Refractive error: +0.25 -0.75 x 75; optic disc at the center of the field; 30° field of view; man patient
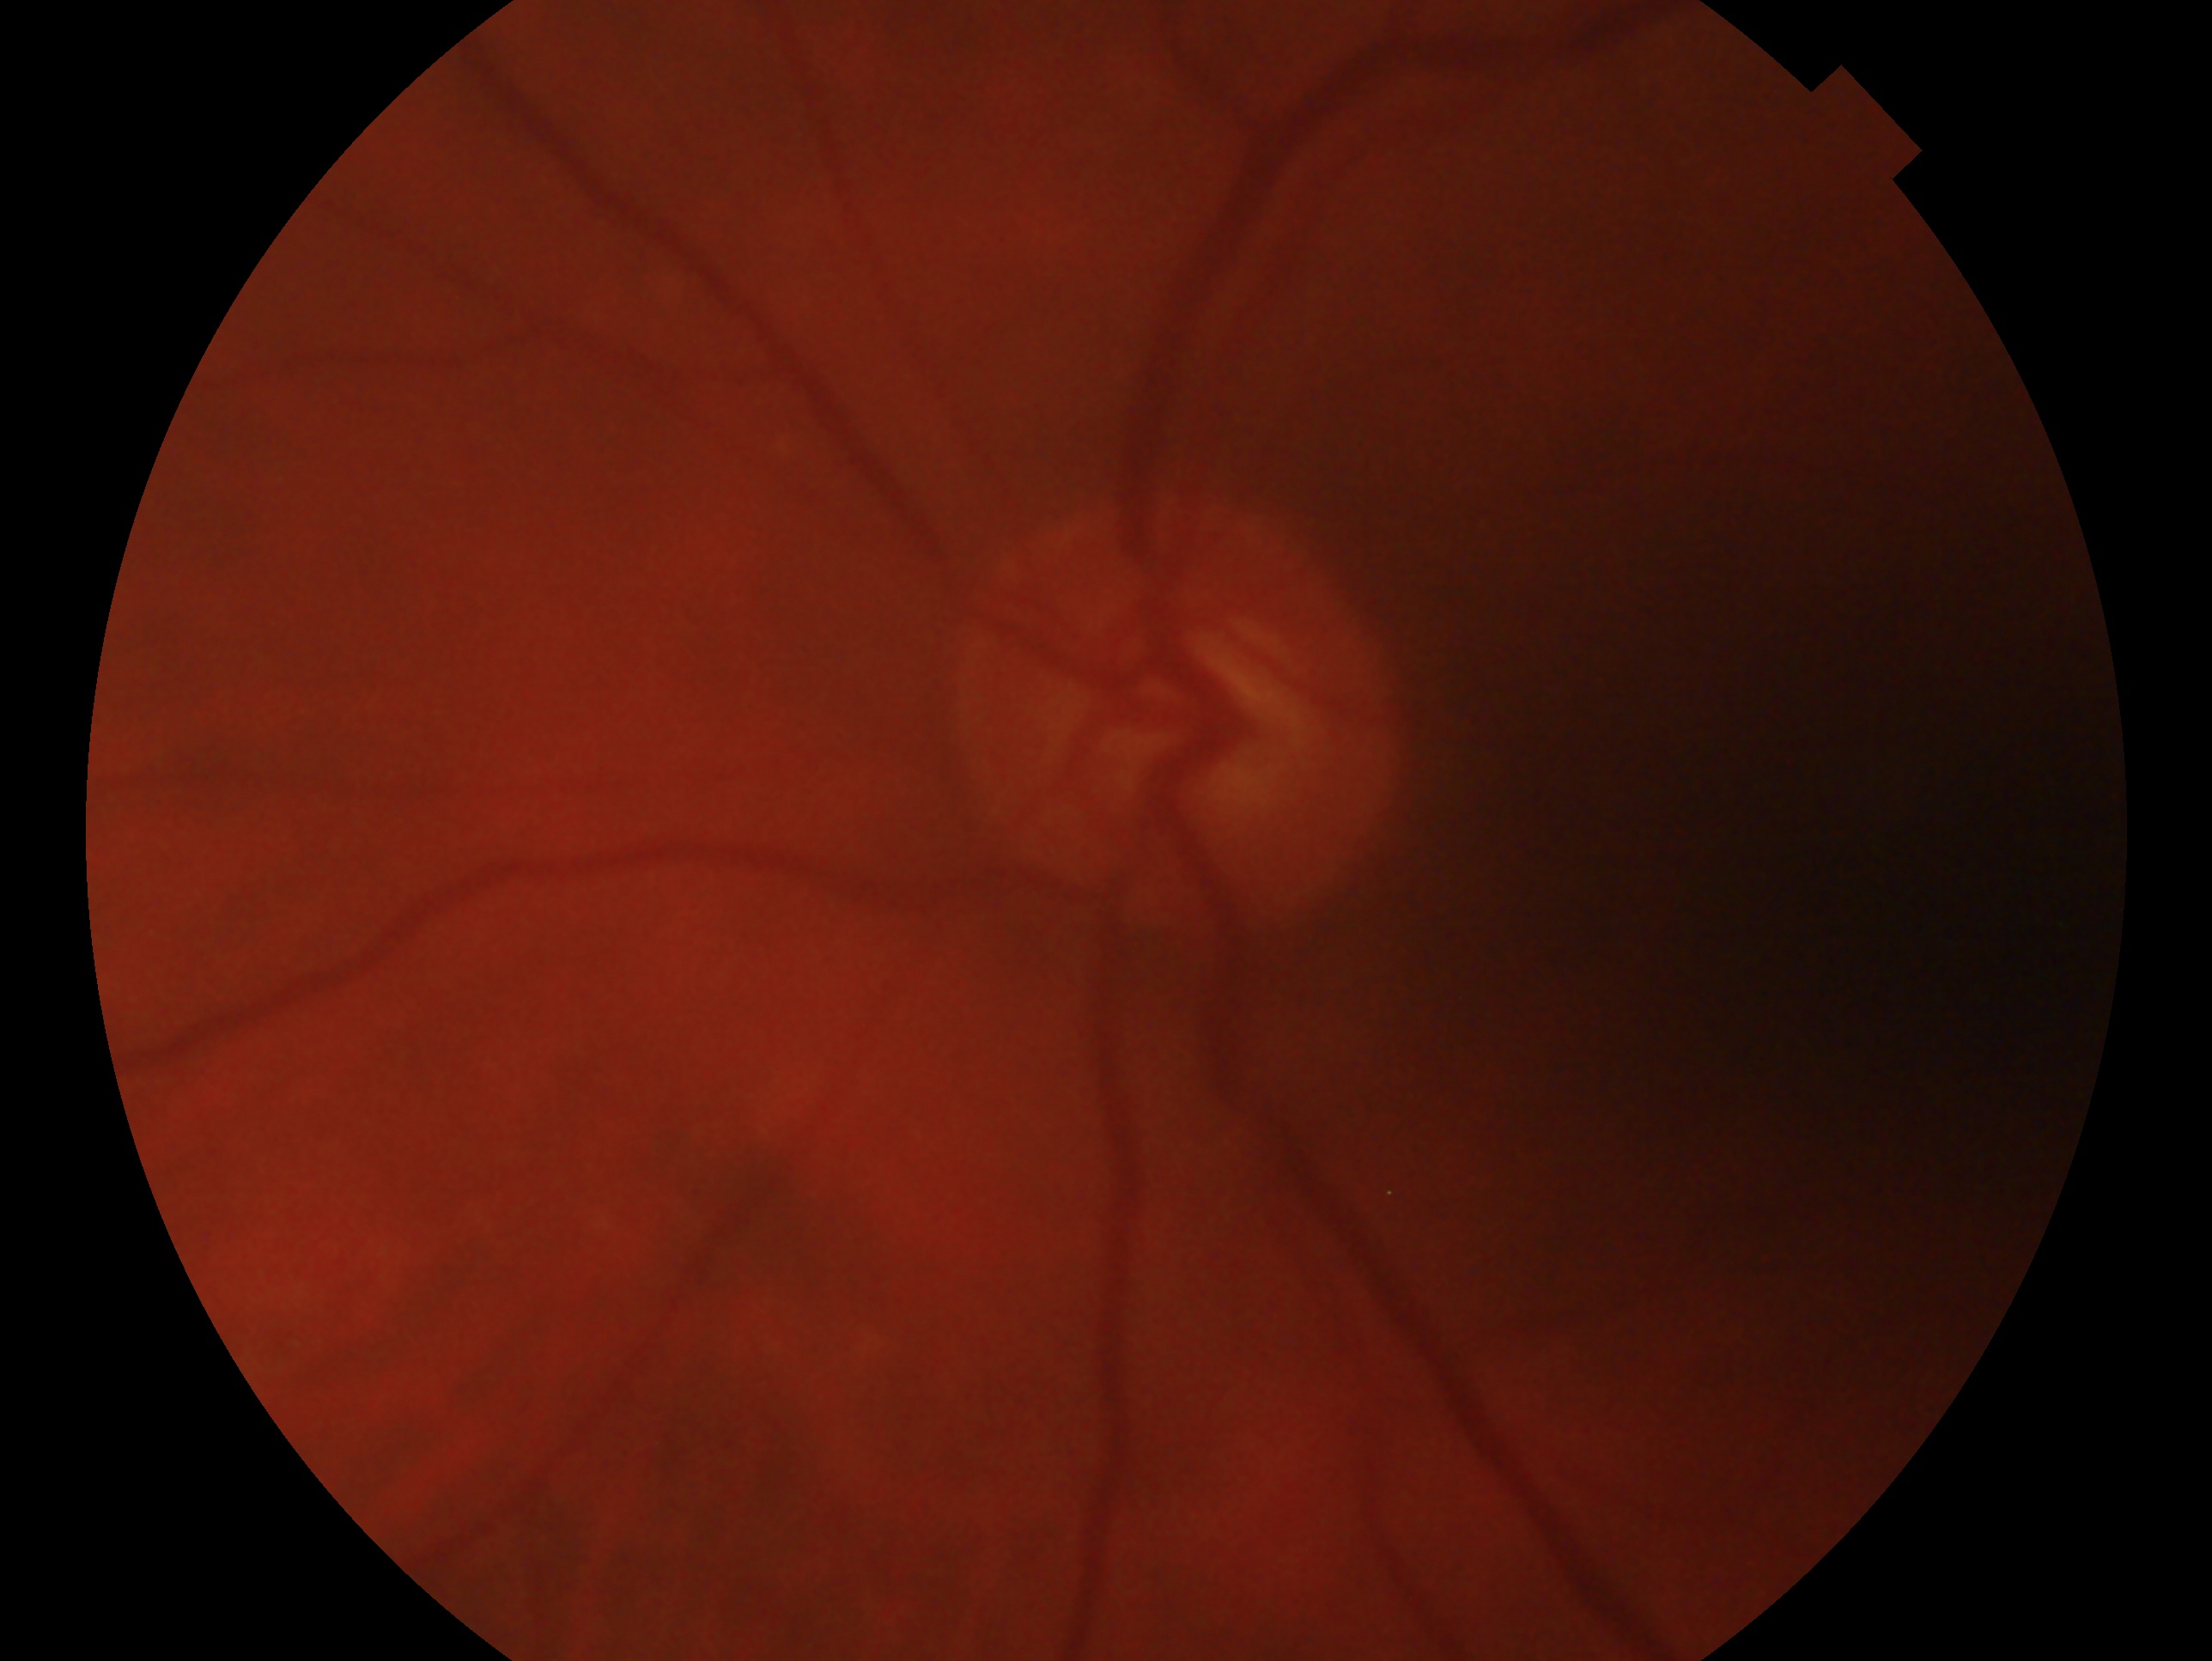 Glaucoma assessment: suspected glaucoma.
This is the OS.